45° FOV:
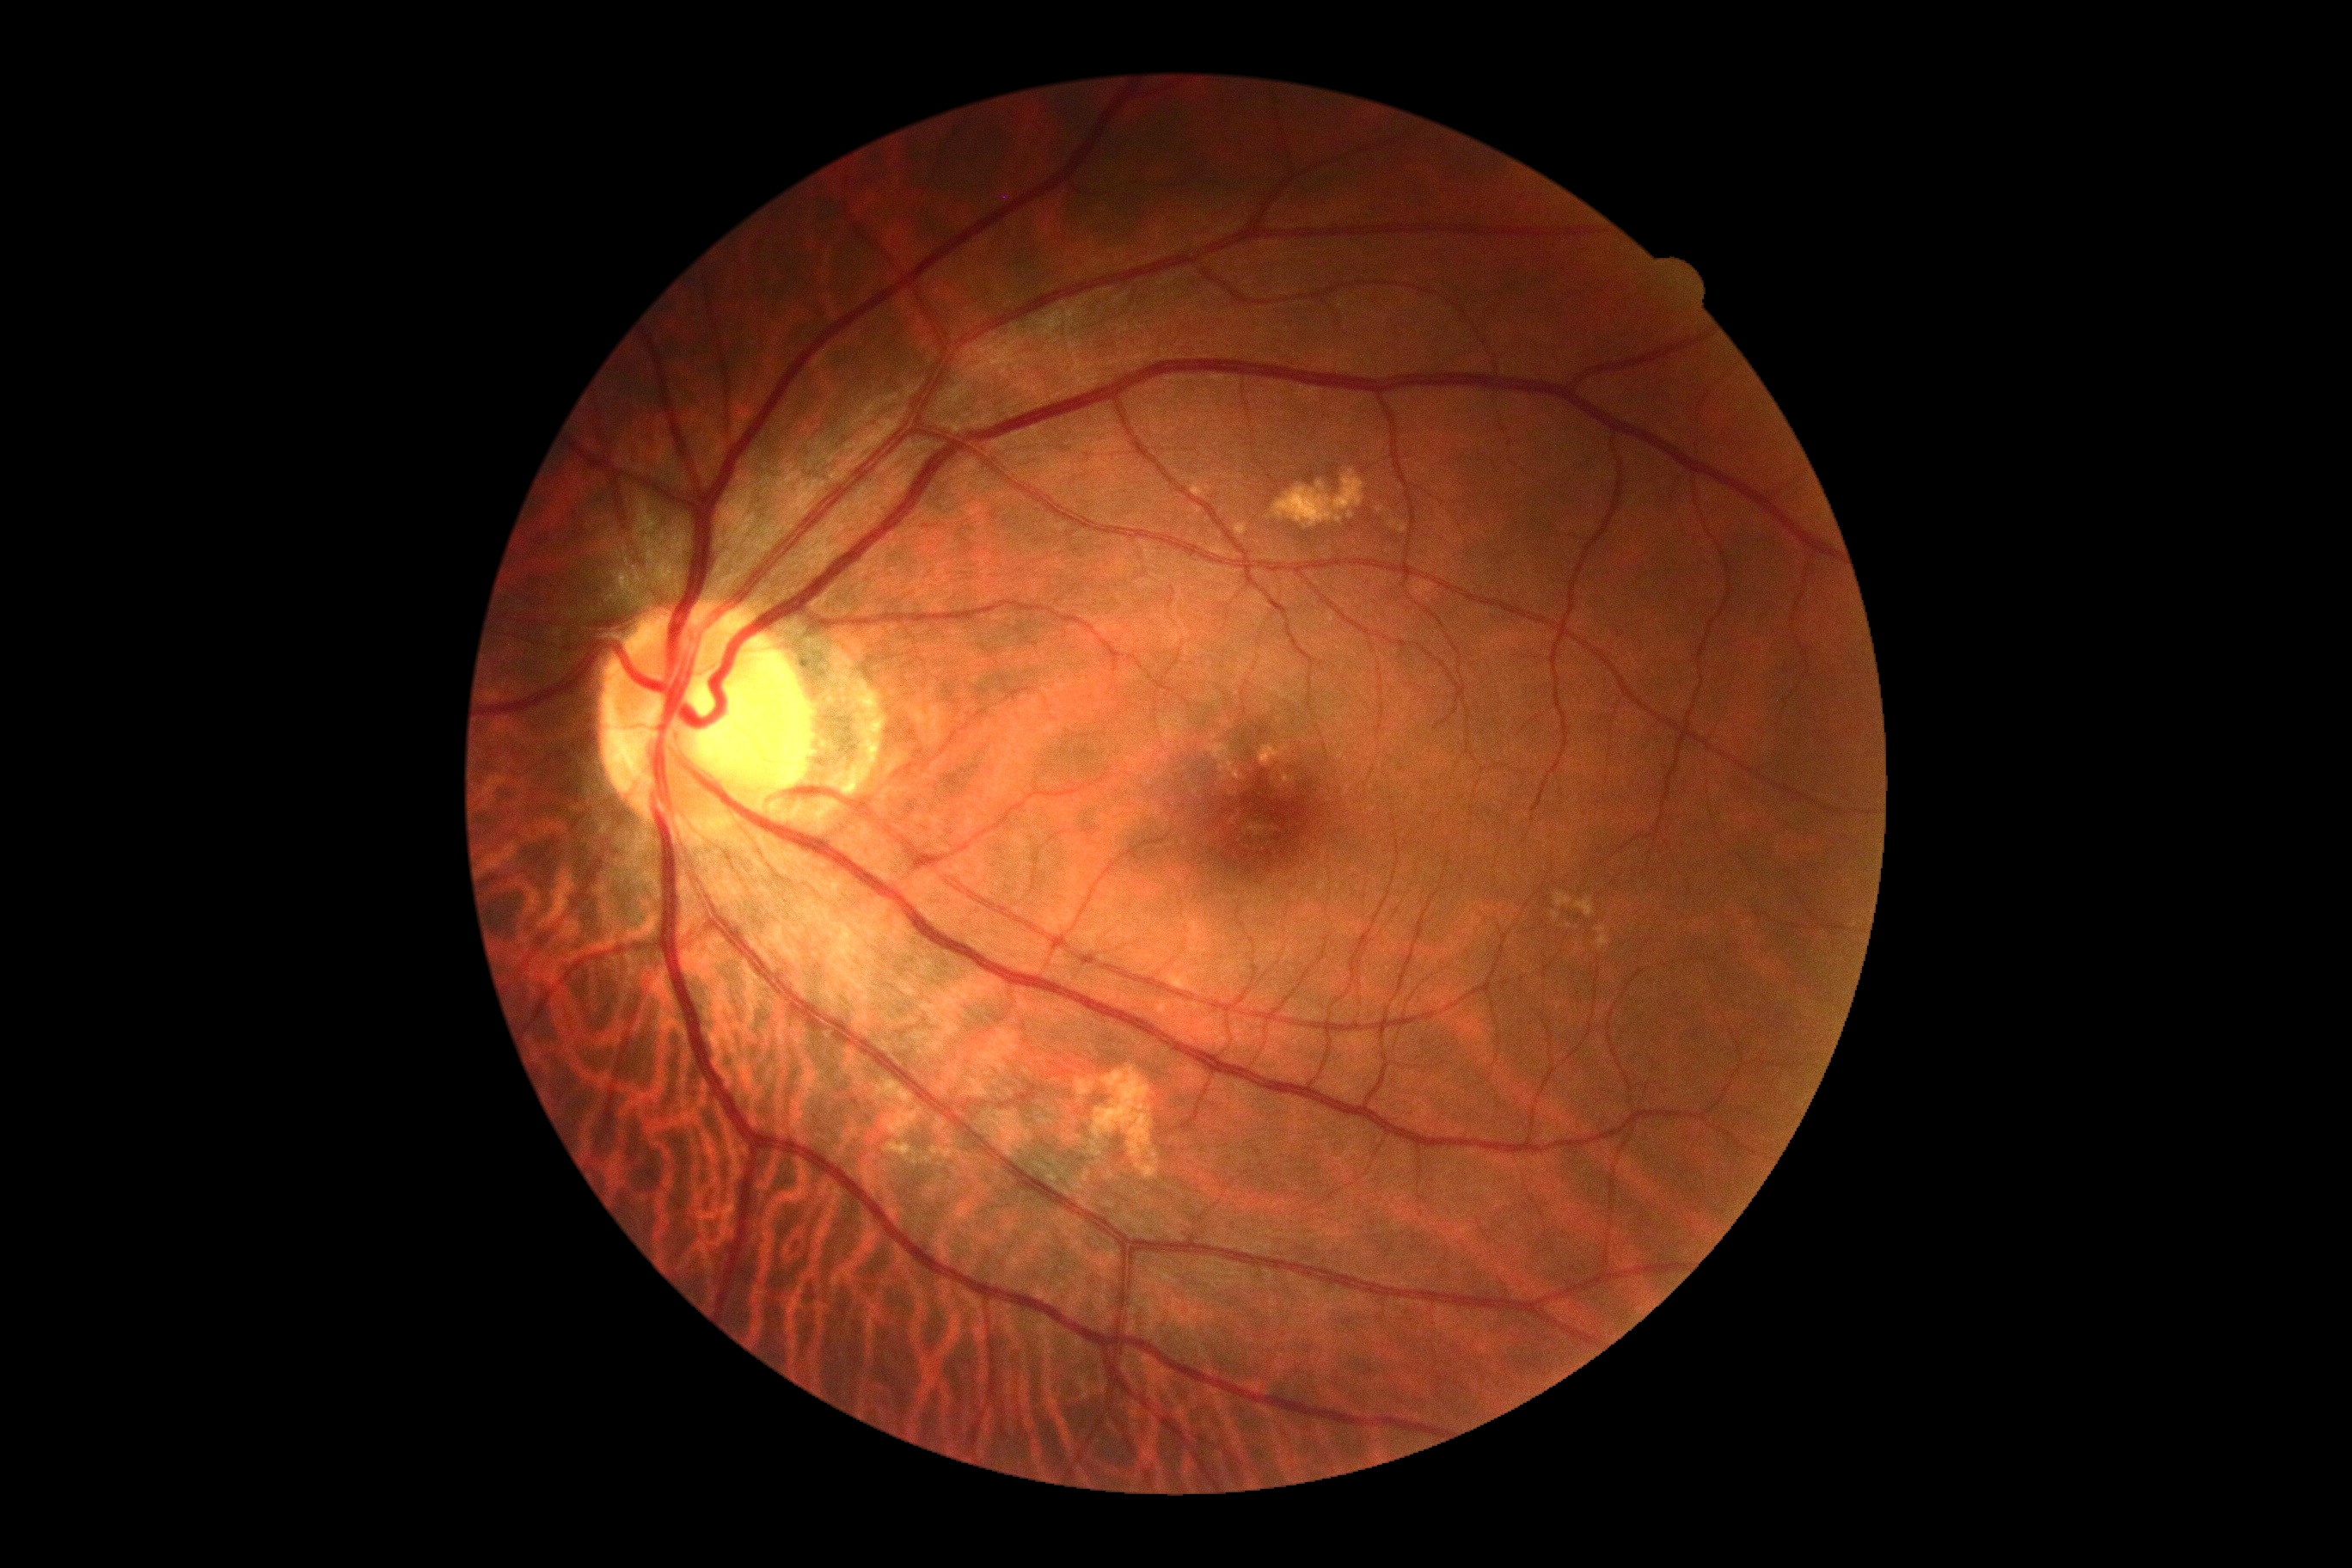 DR severity: grade 0.